1380 x 1382 pixels.
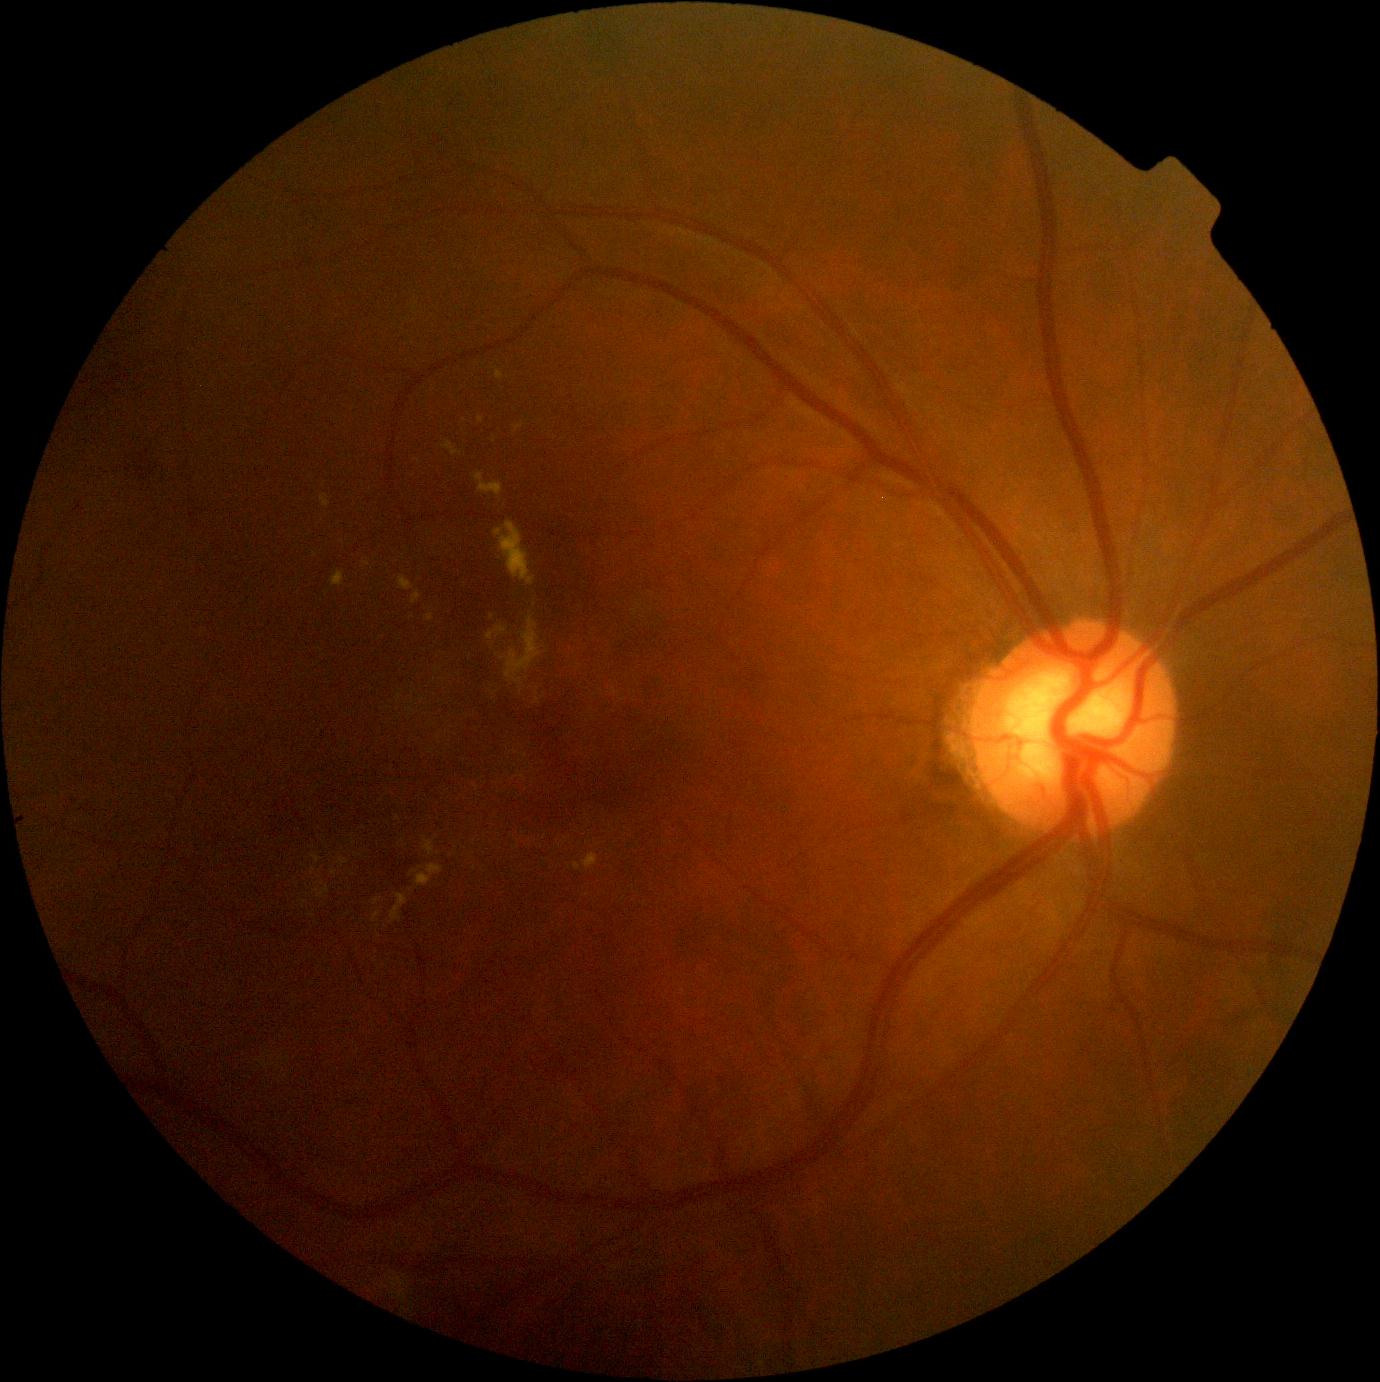

dr_grade: 2
dr_category: non-proliferative diabetic retinopathy